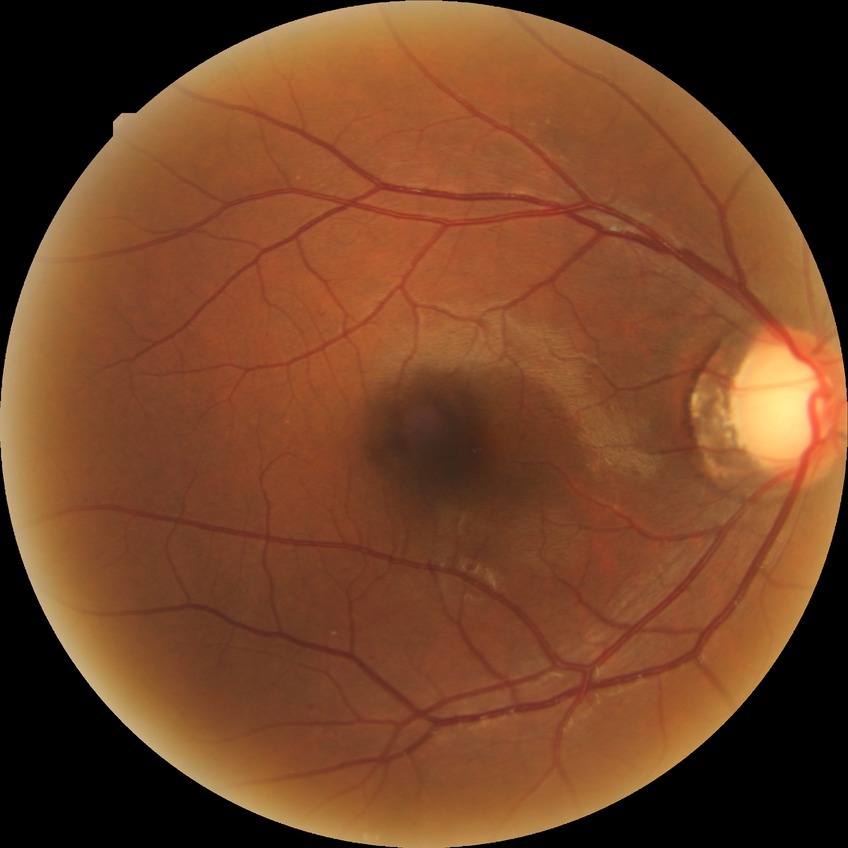 DR stage: SDR.